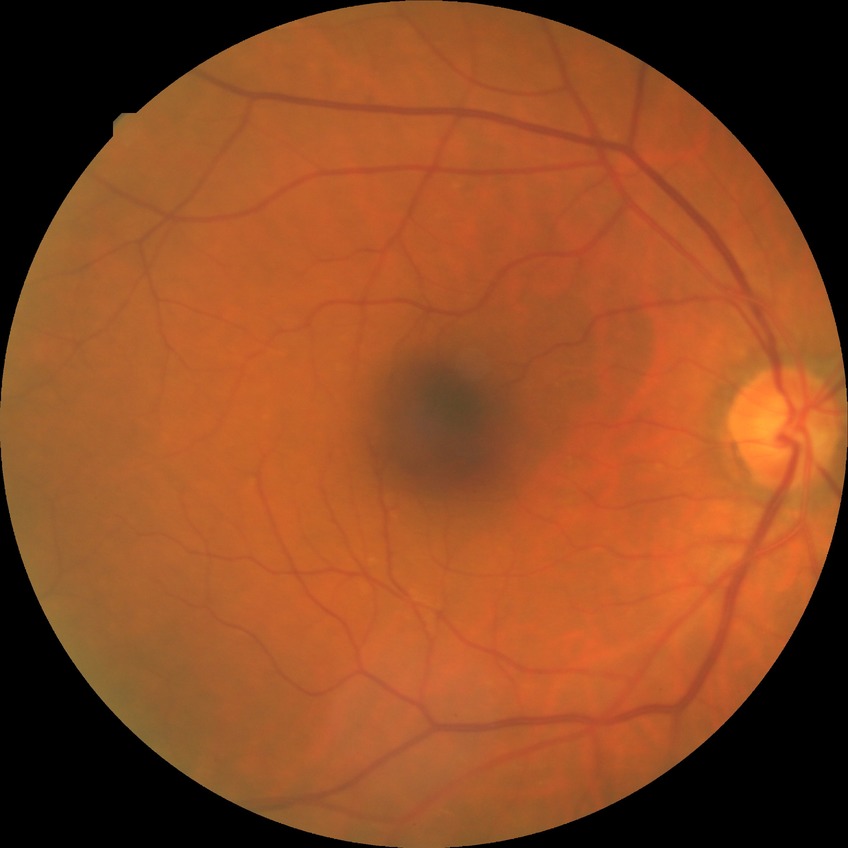 Annotations:
* diabetic retinopathy (DR): NDR (no diabetic retinopathy)